Color fundus image, acquired with a NIDEK AFC-230, 45 degree fundus photograph, nonmydriatic fundus photograph, image size 848x848:
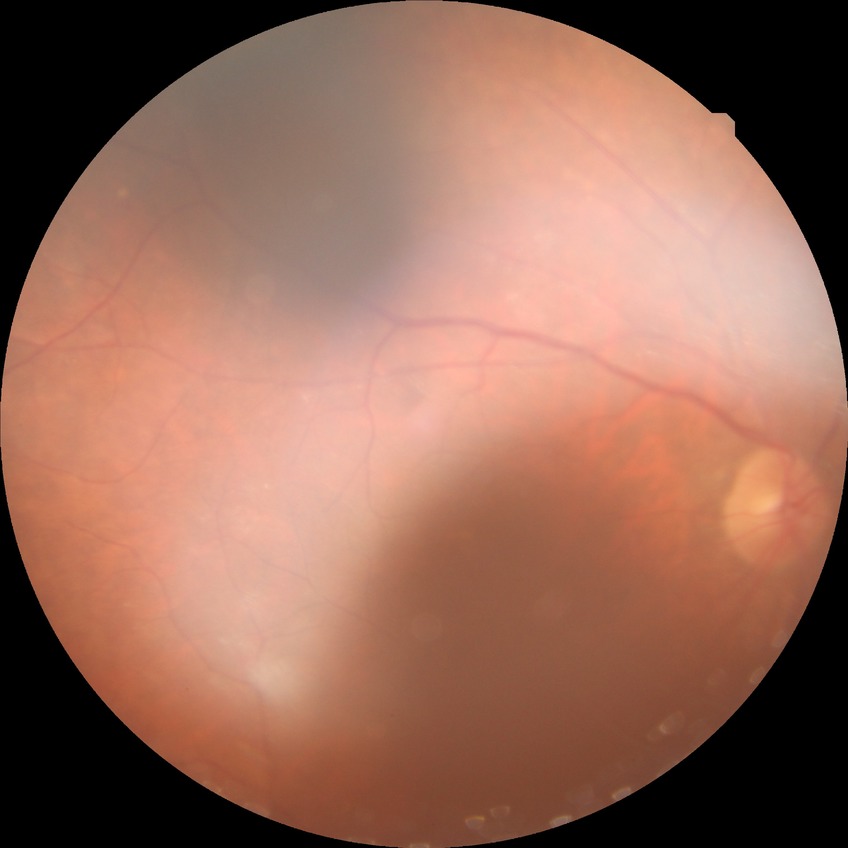

Diabetic retinopathy severity is no diabetic retinopathy.